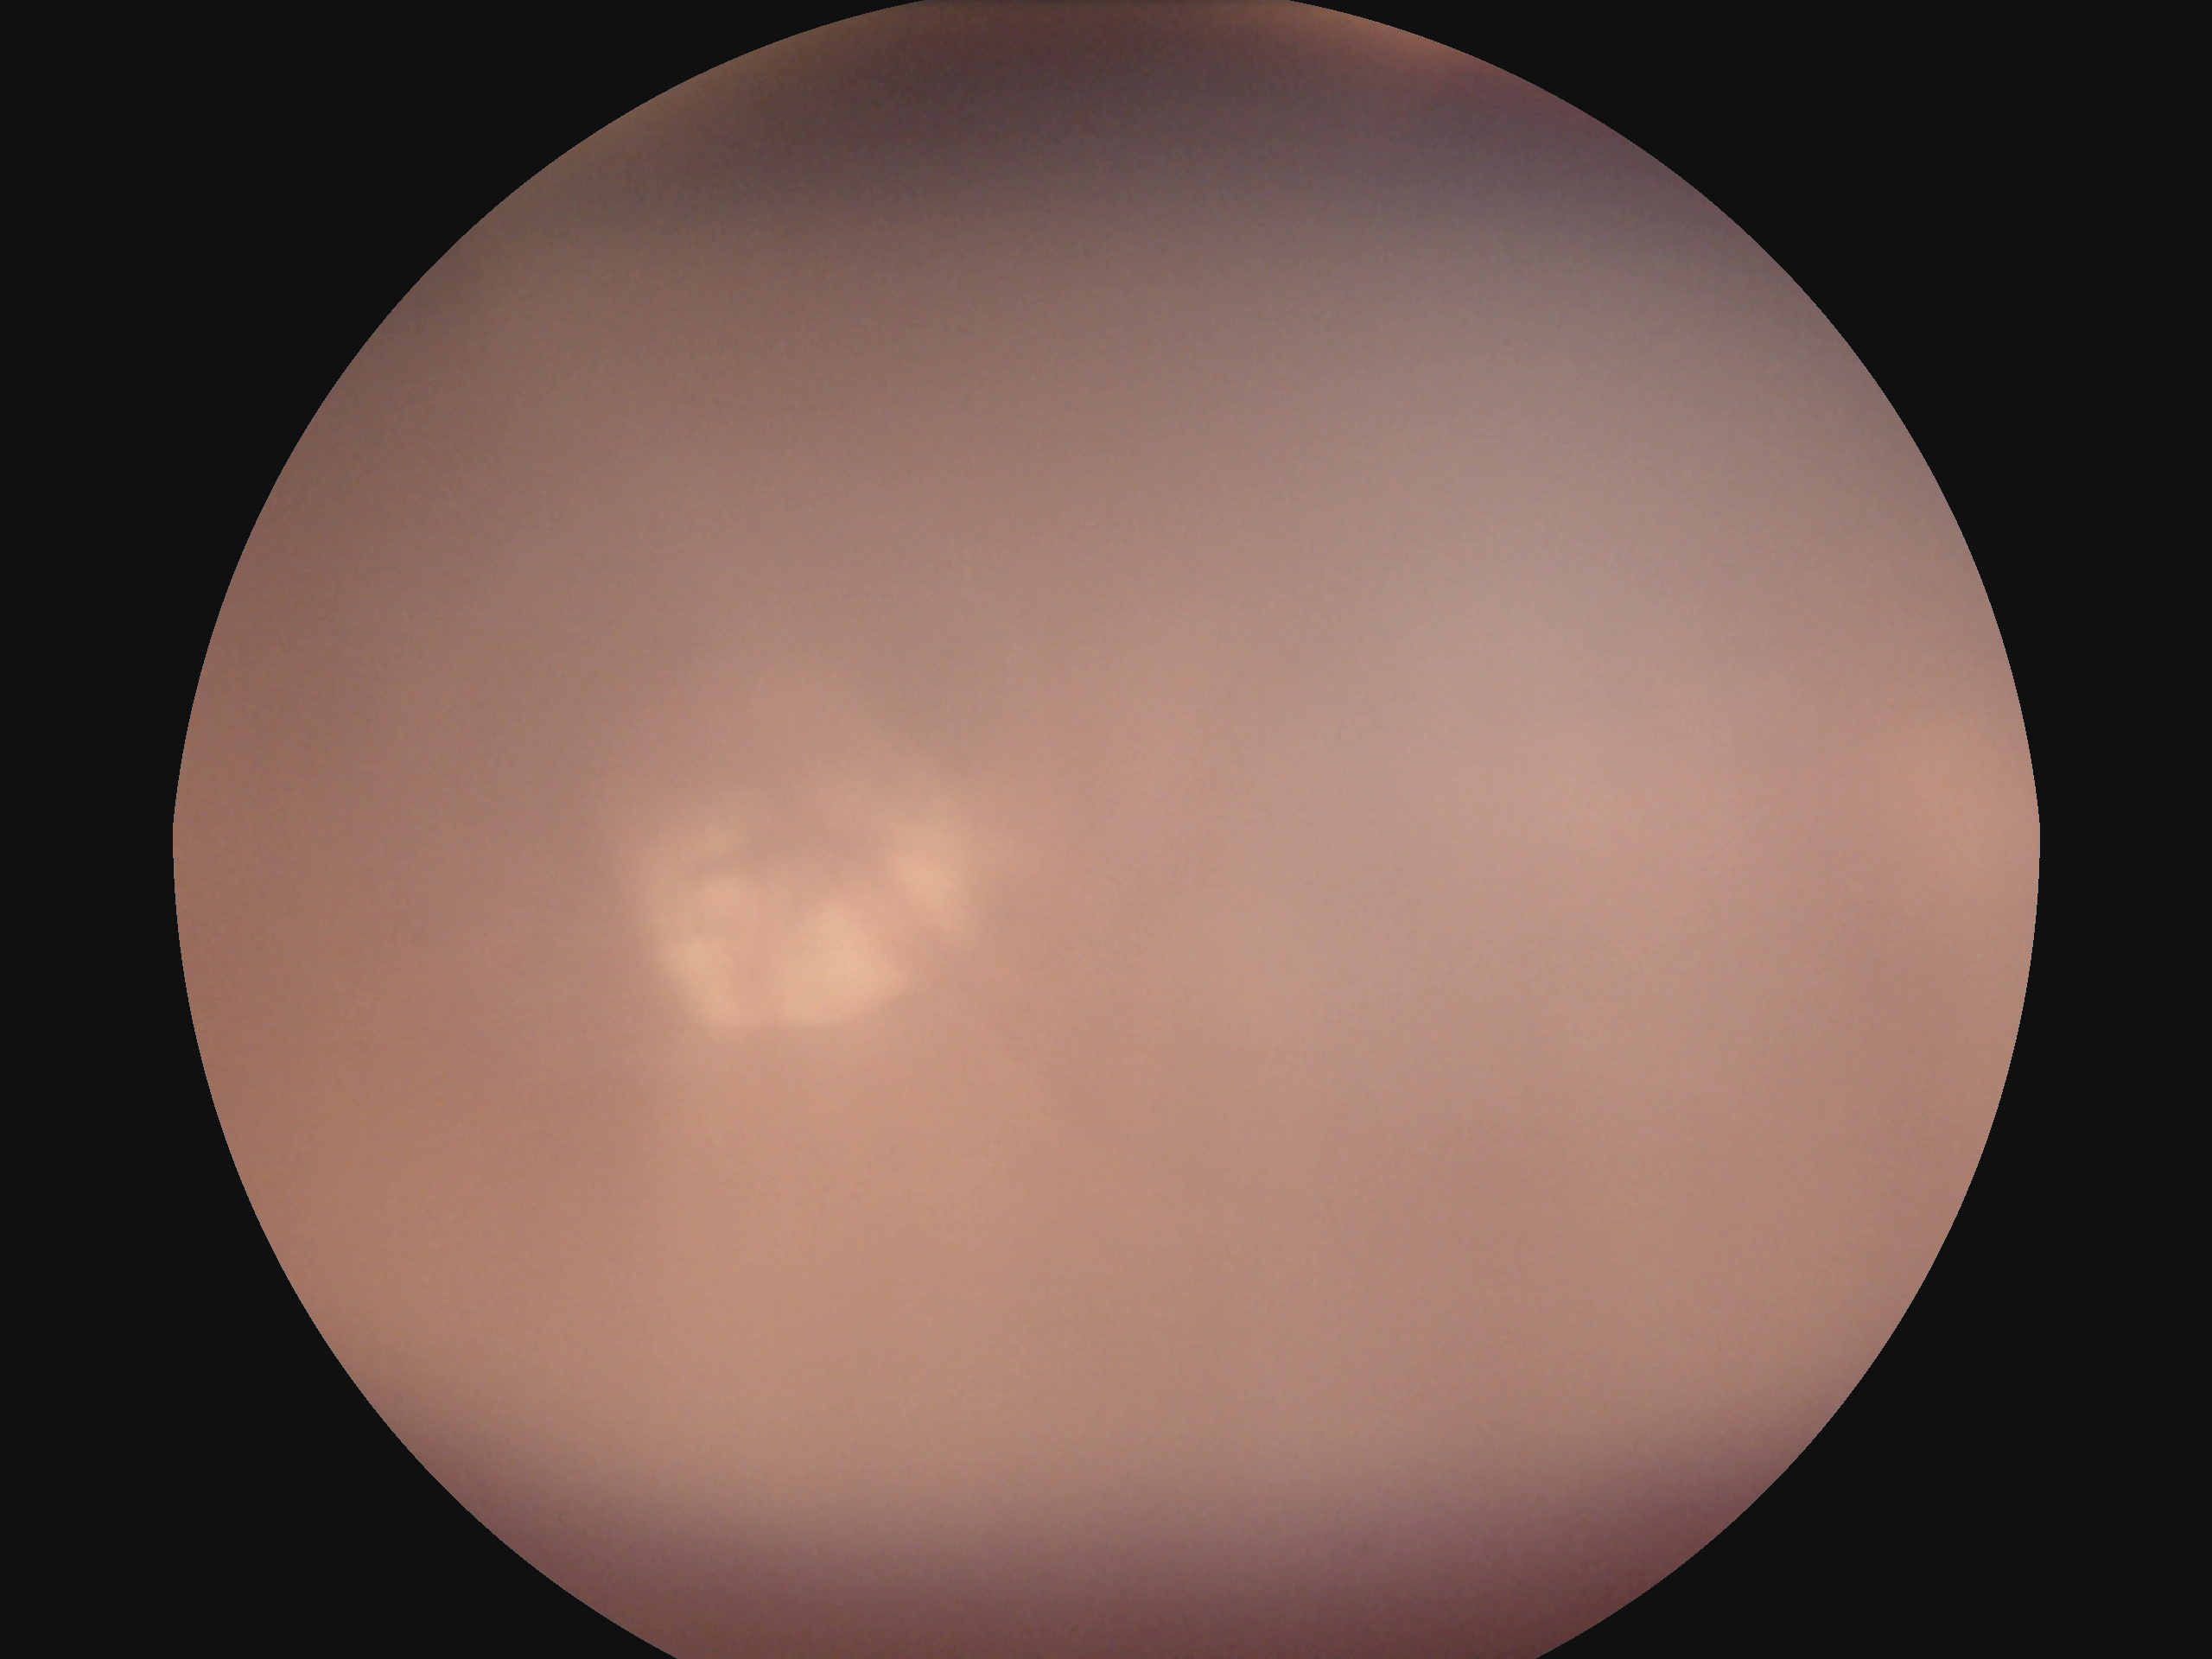 Diabetic retinopathy severity: ungradable.
The image cannot be graded for diabetic retinopathy.